45-degree field of view, 2212x1659px — 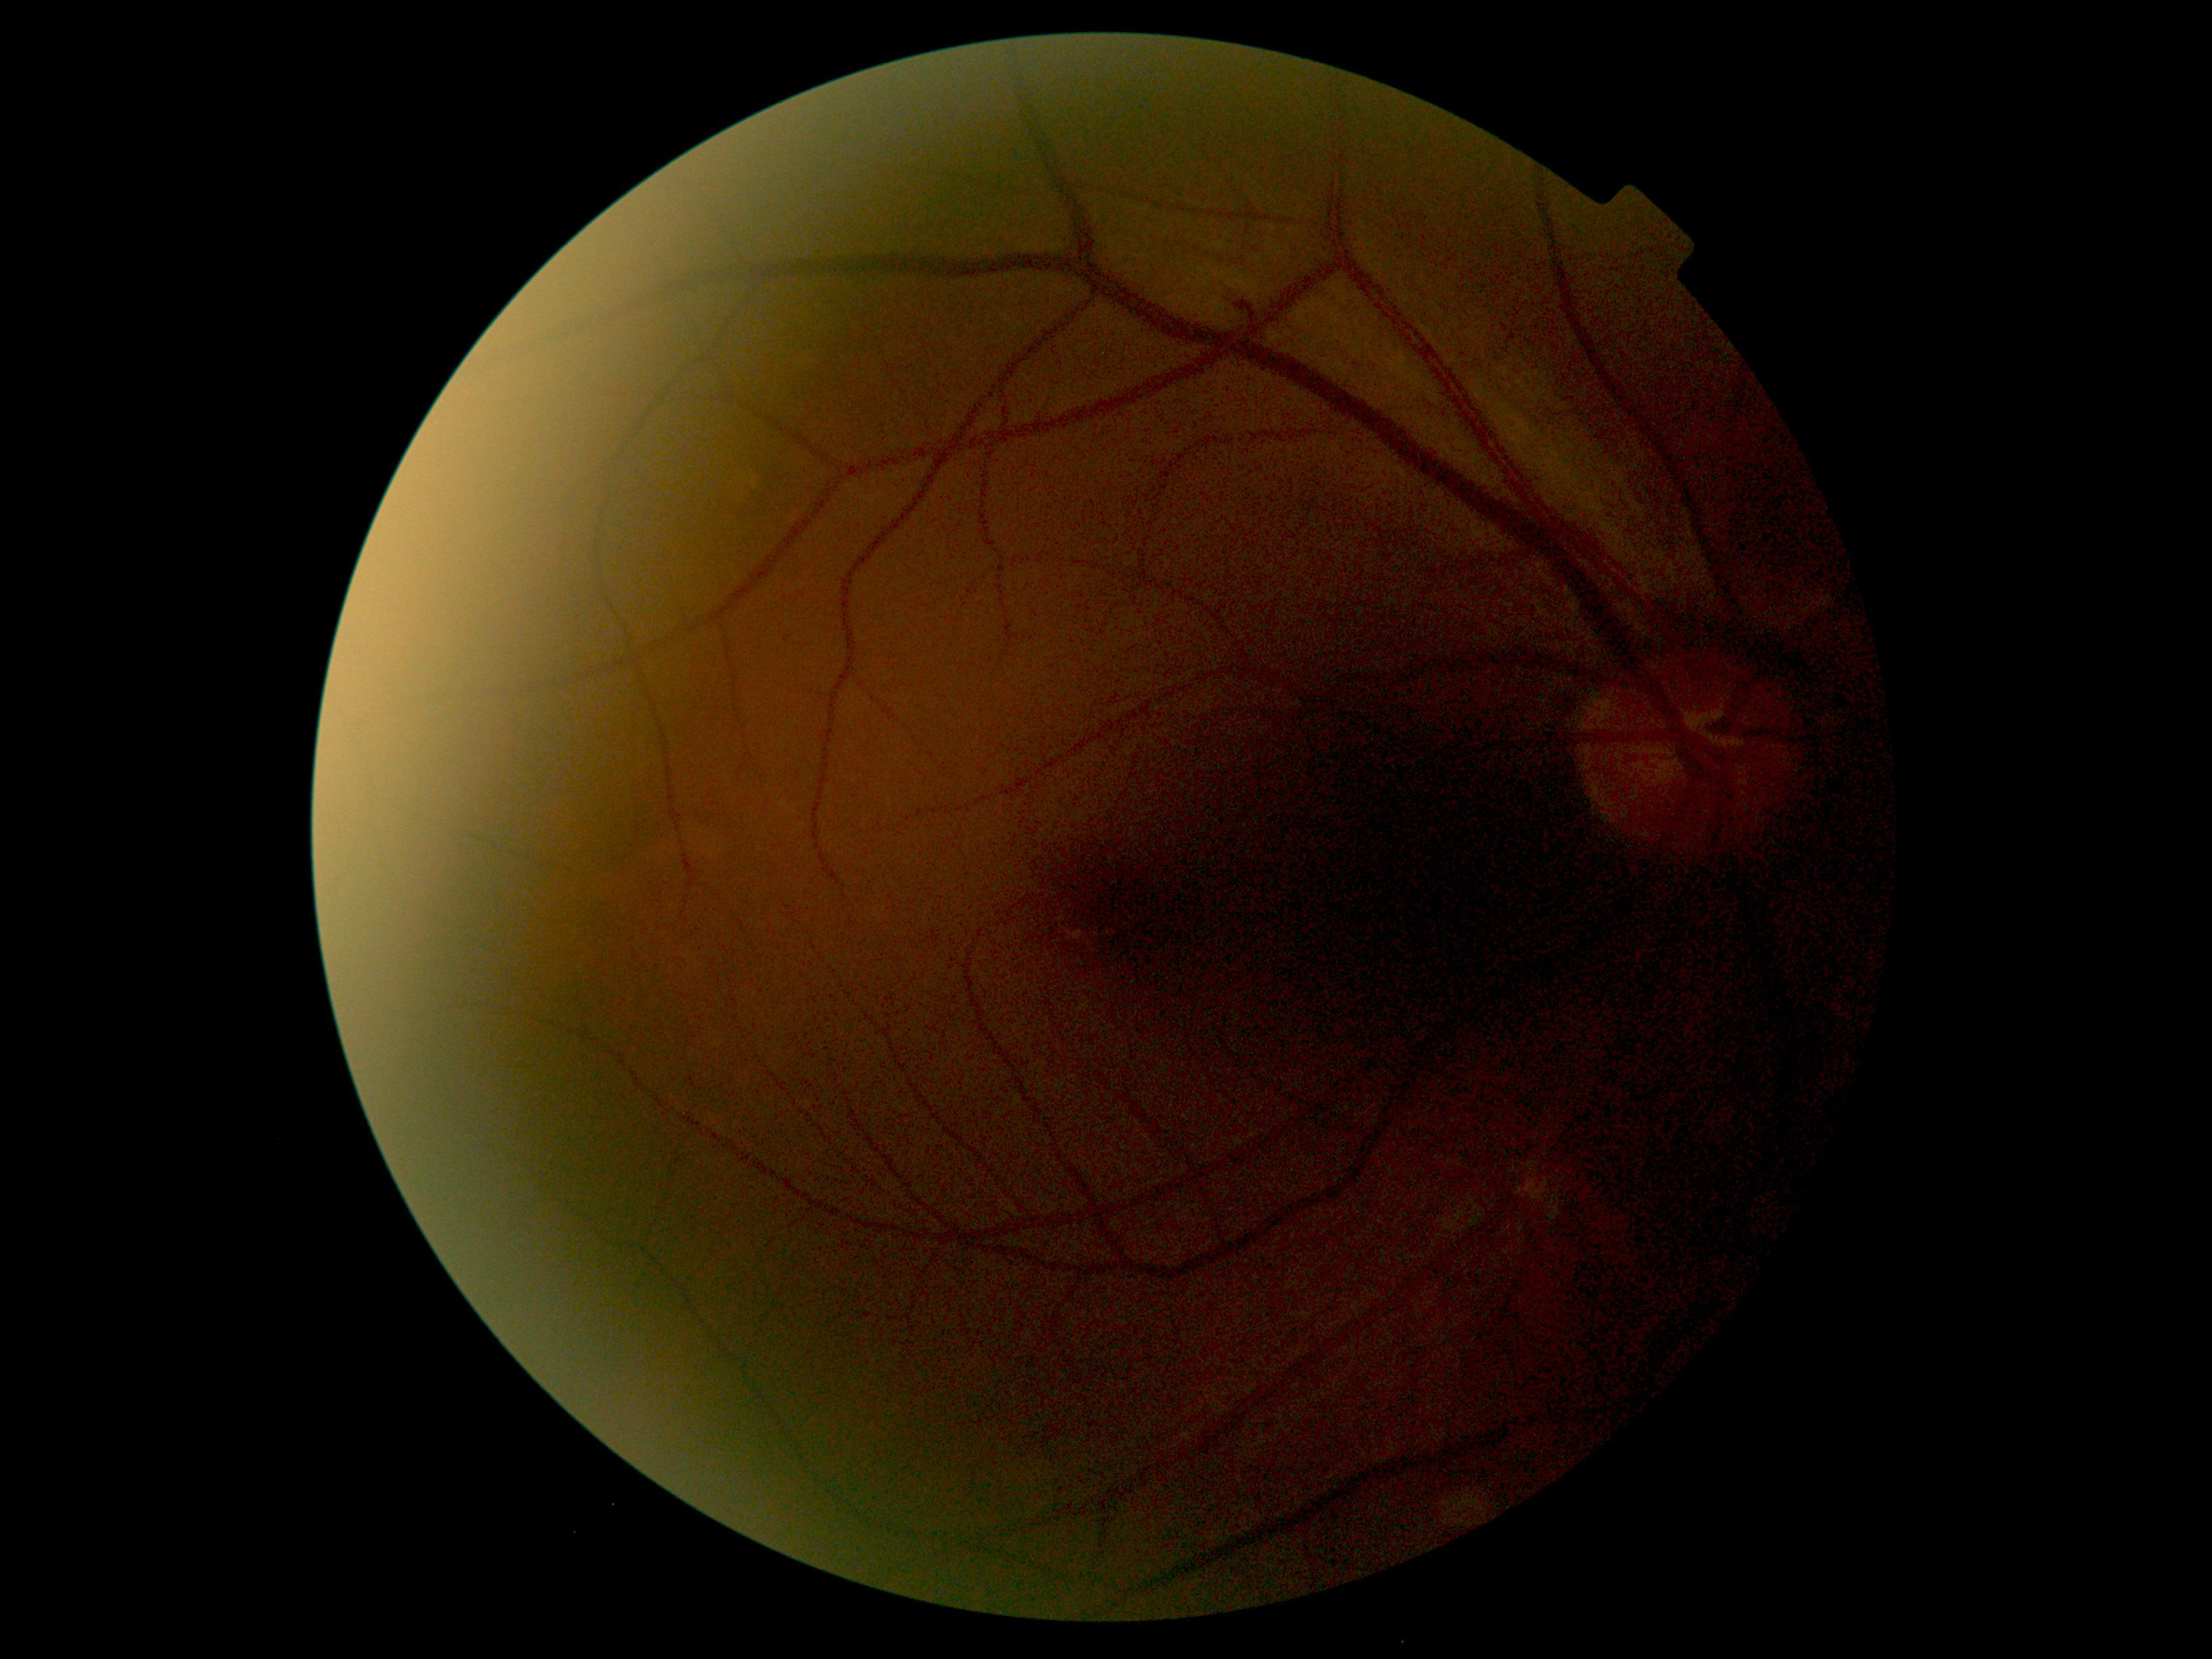 Diabetic retinopathy (DR): grade 2 (moderate NPDR) — more than just microaneurysms but less than severe NPDR.